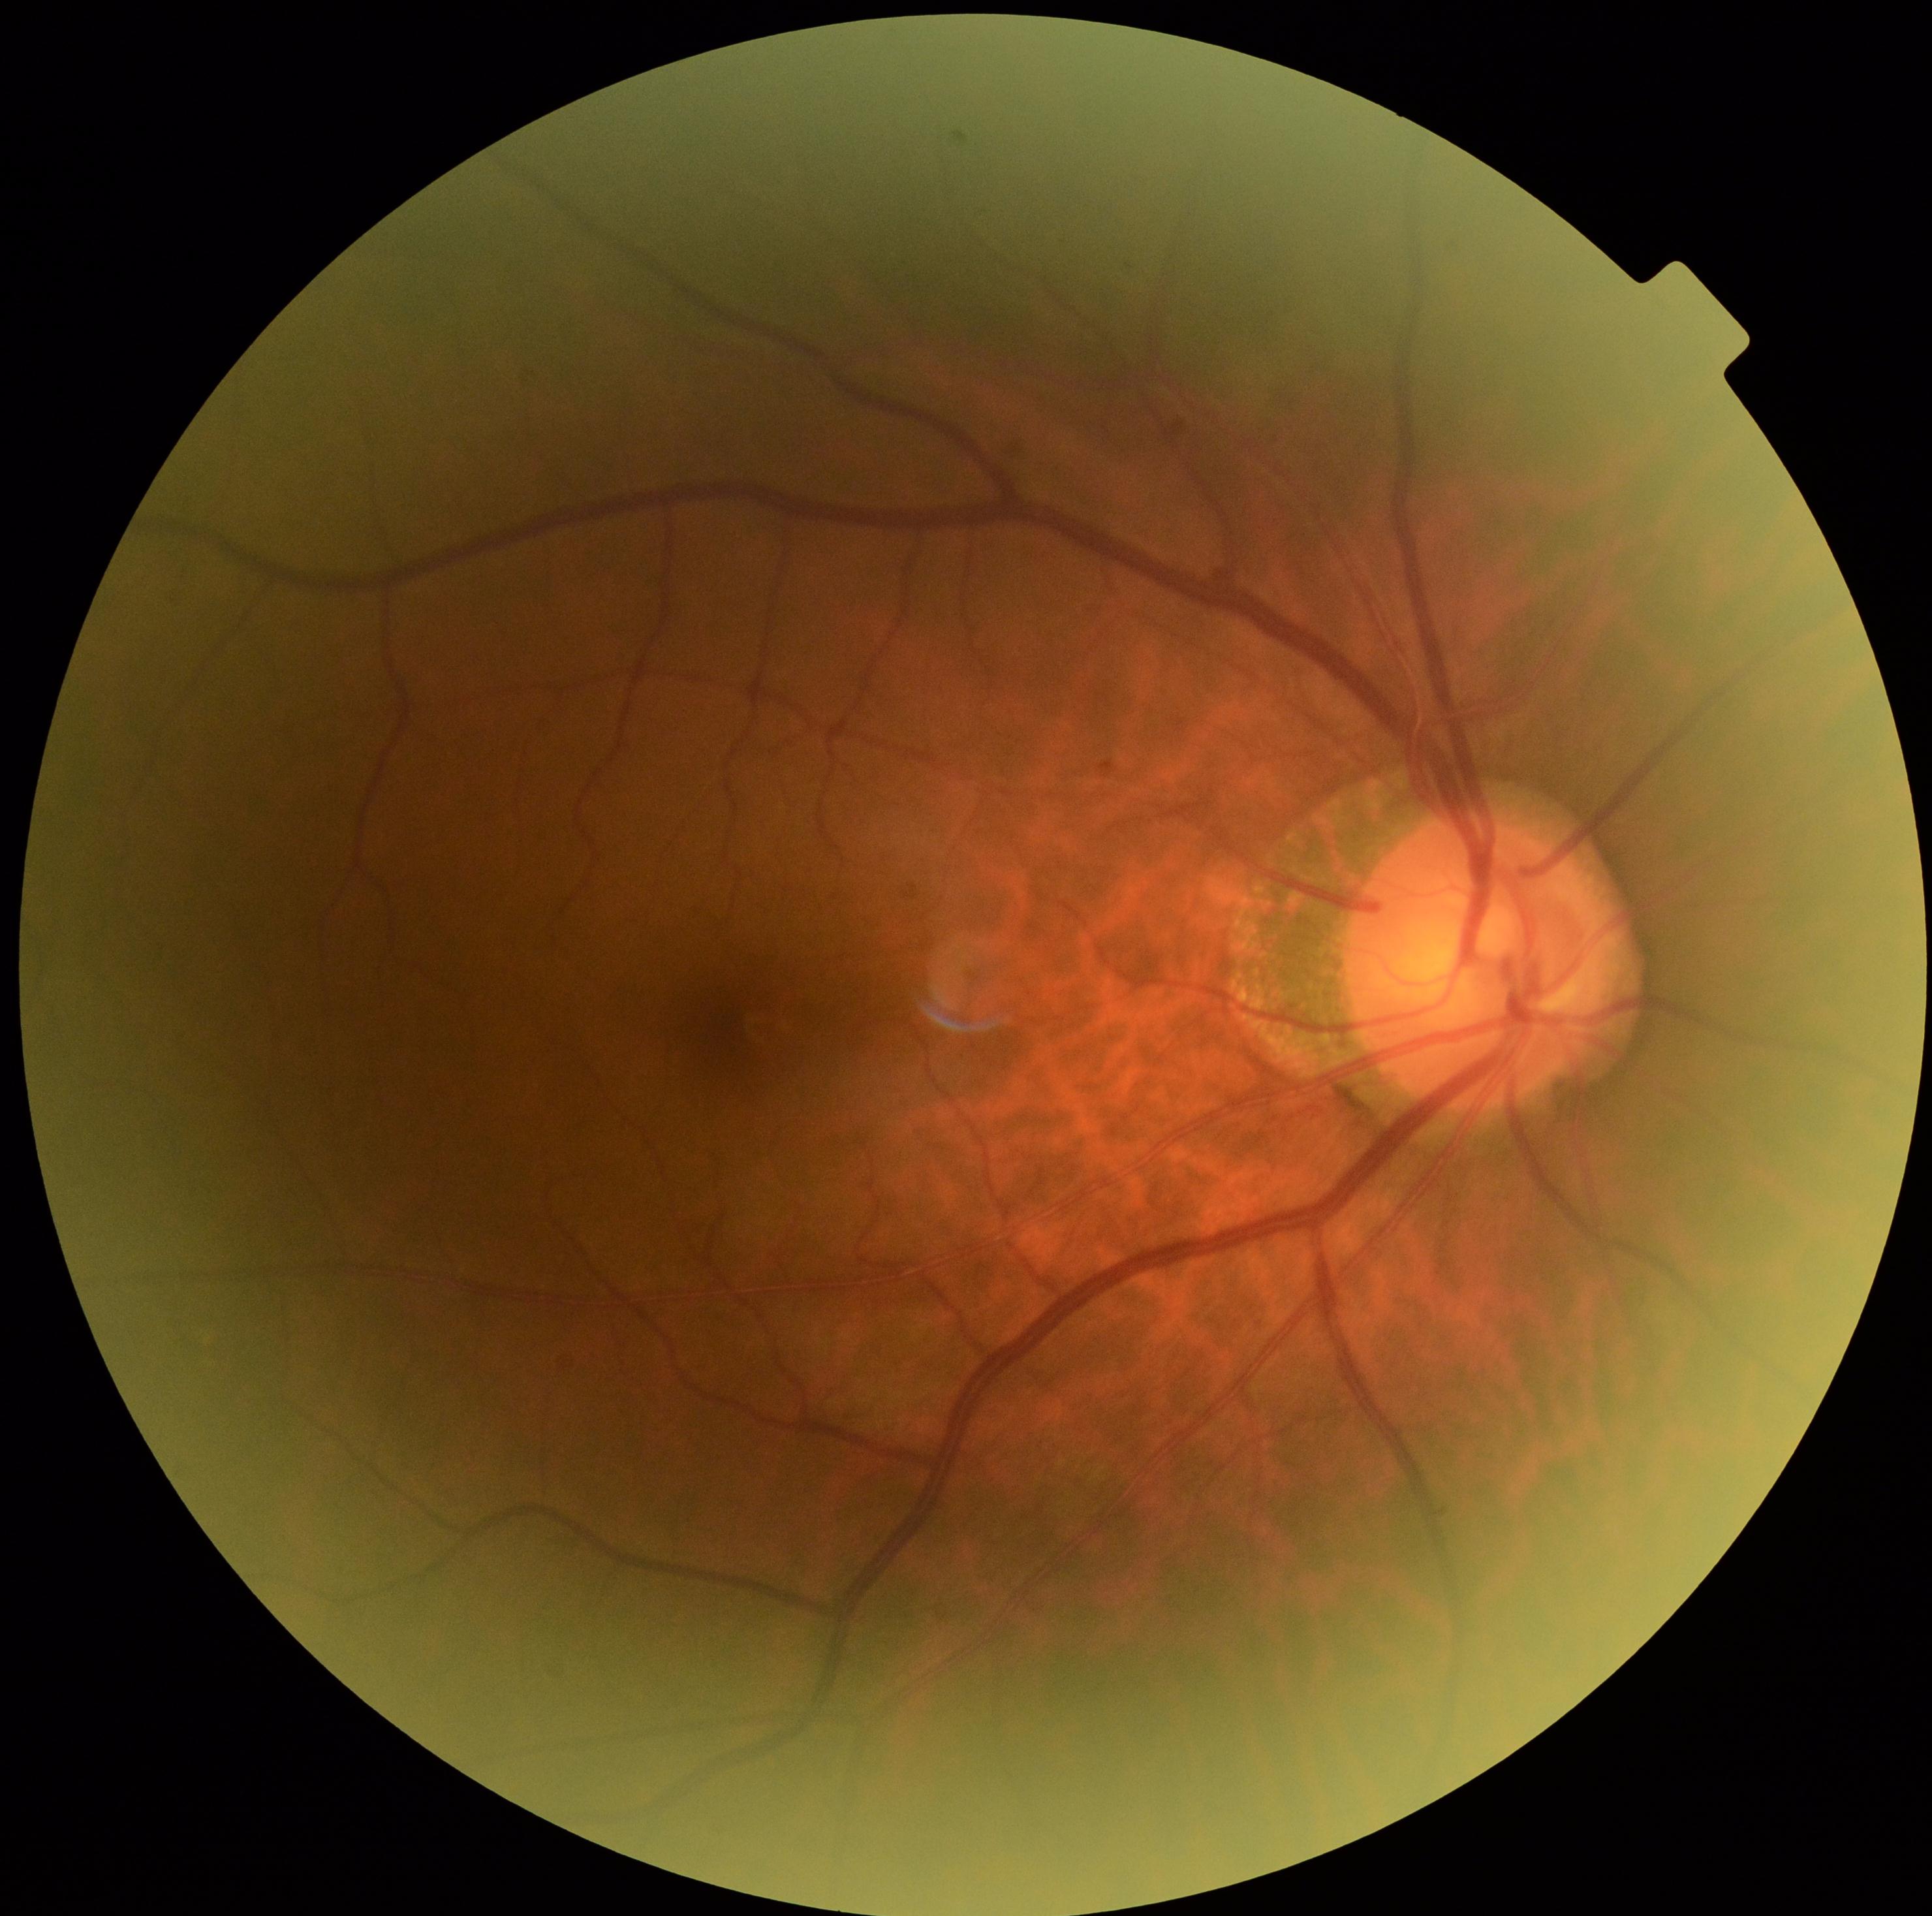

Diabetic retinopathy is no apparent retinopathy (grade 0) — no visible signs of diabetic retinopathy.